Fundus photo: 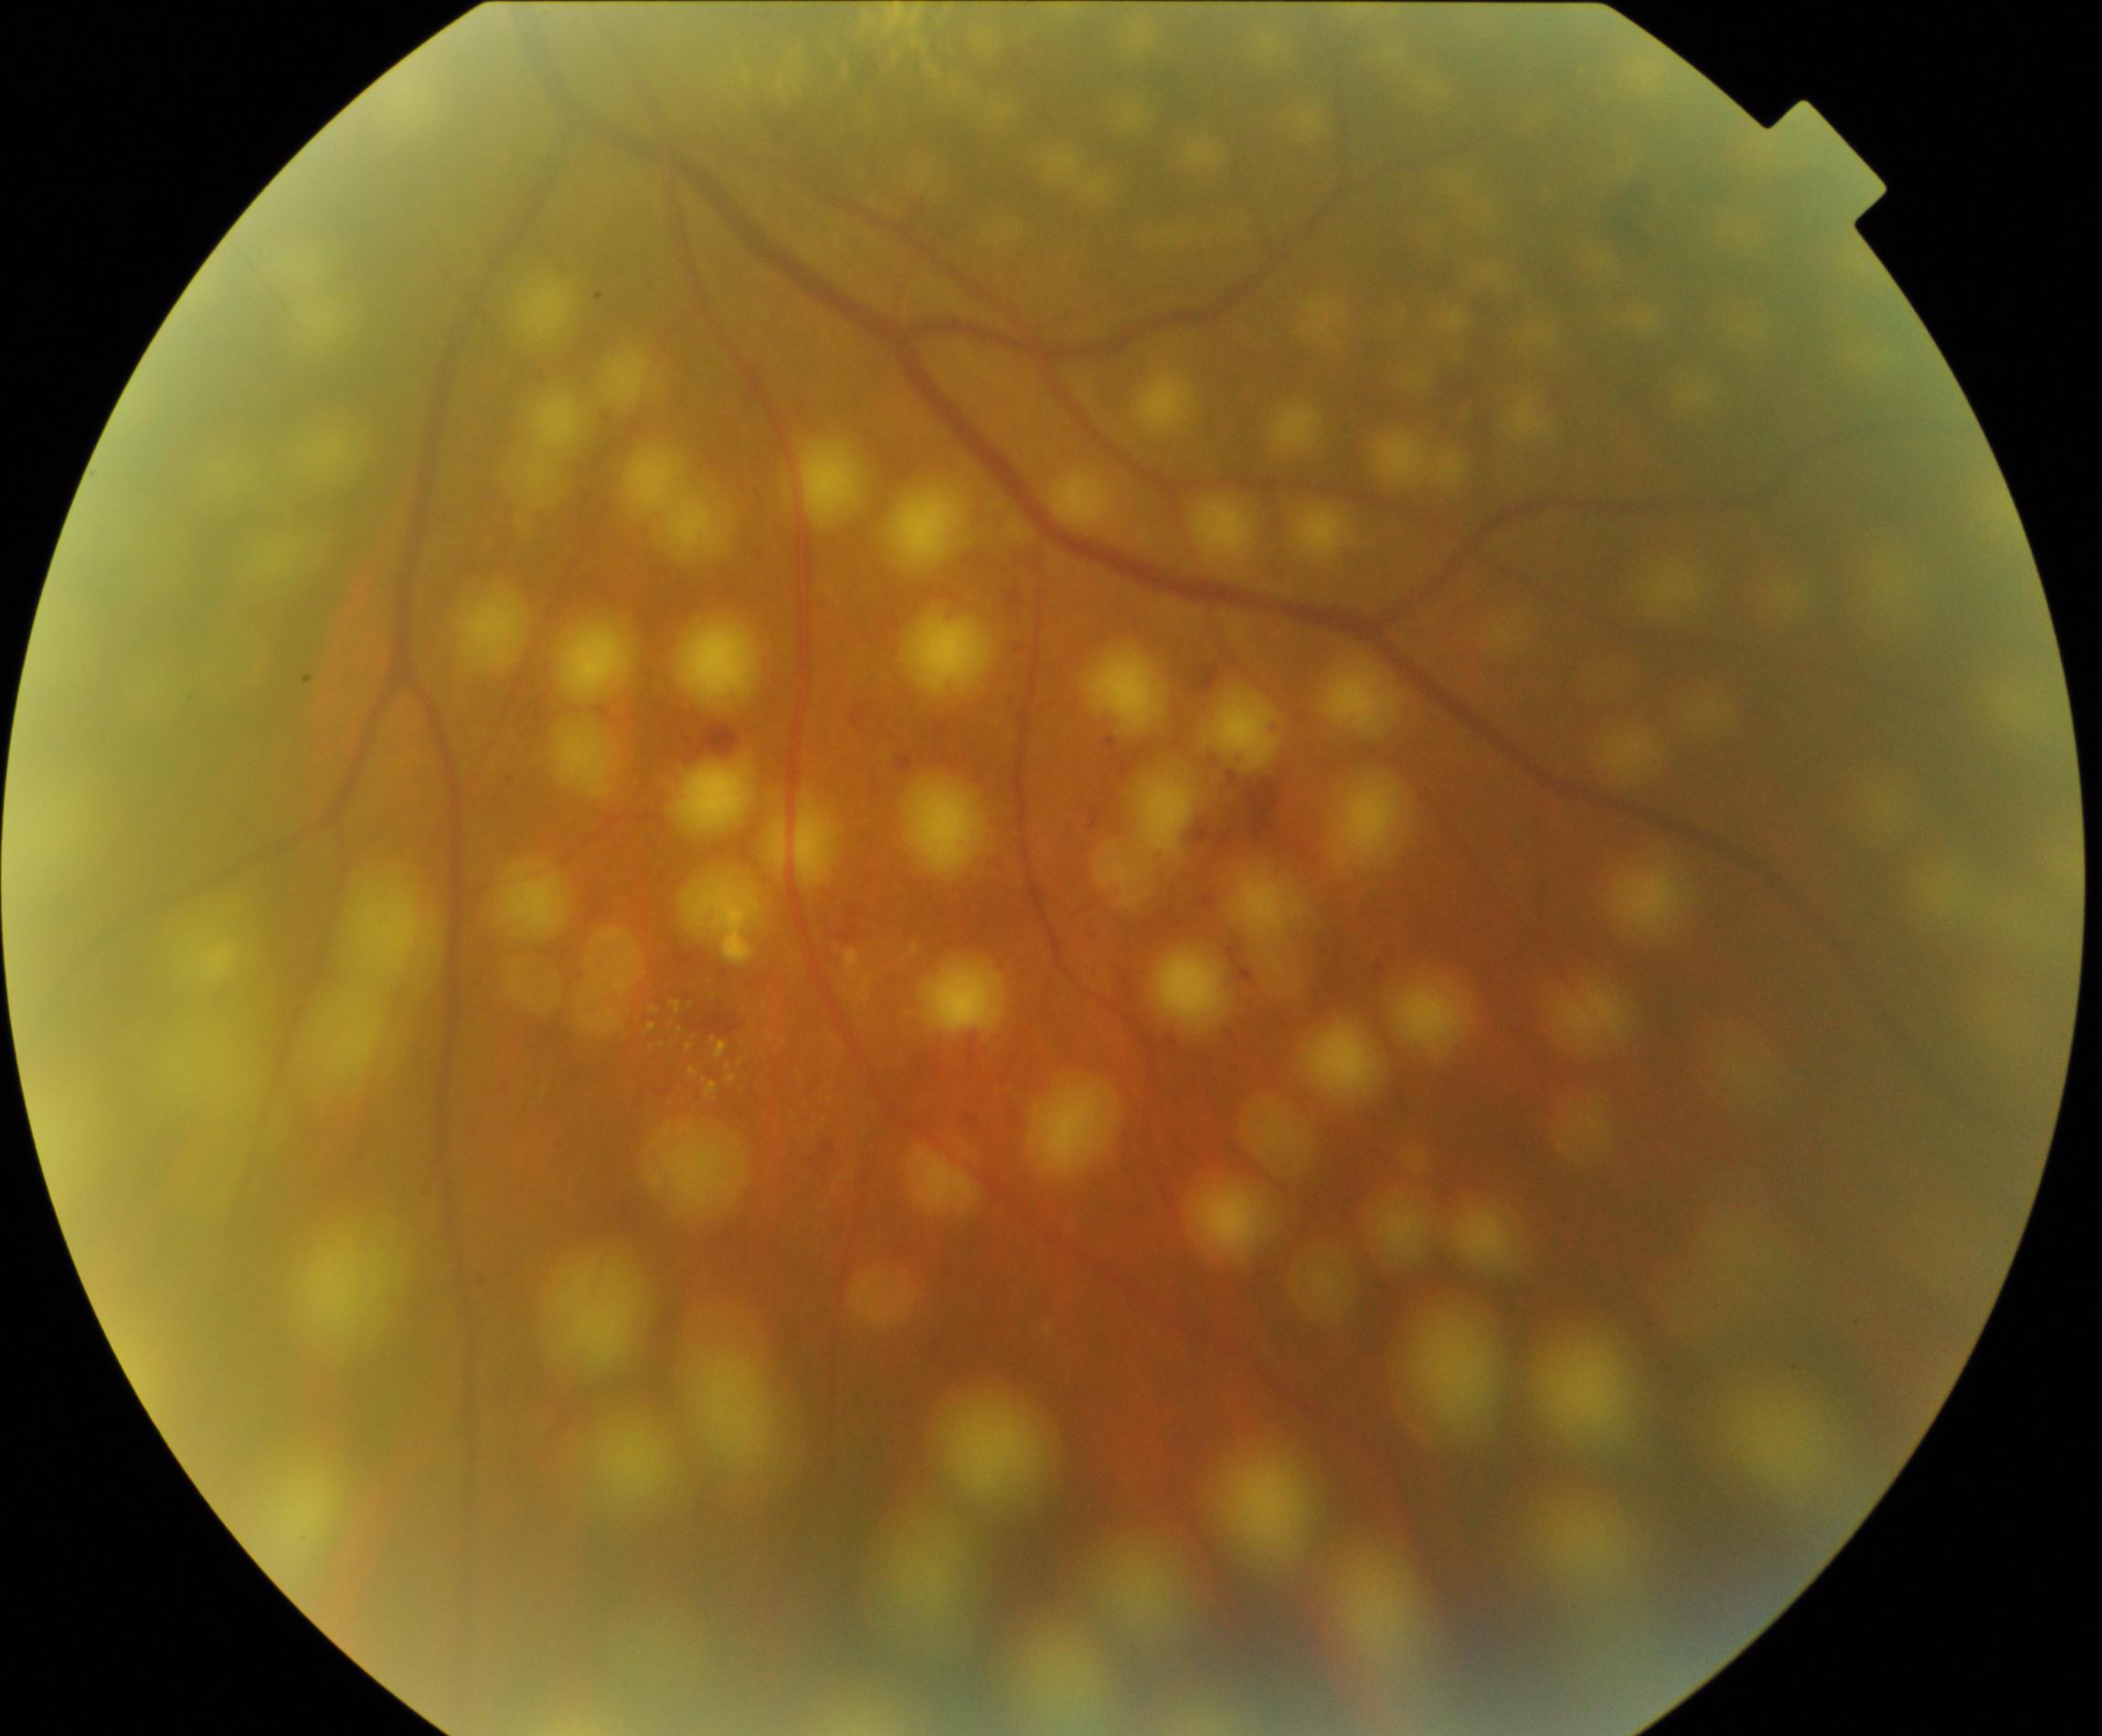 Laser spots visible.